RetCam wide-field infant fundus image
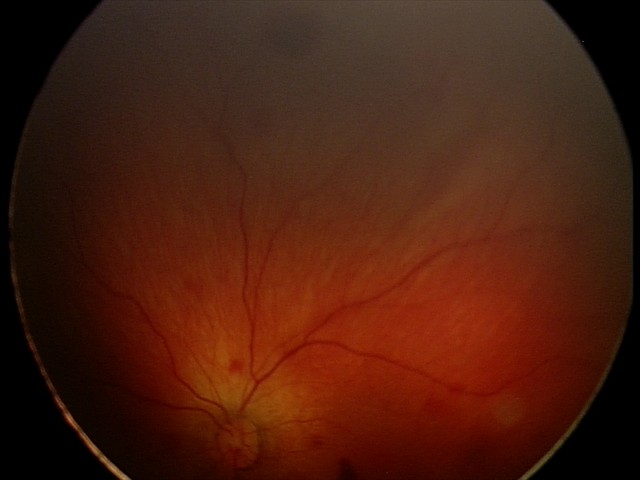
Screening series with retinal hemorrhages.